45-degree field of view
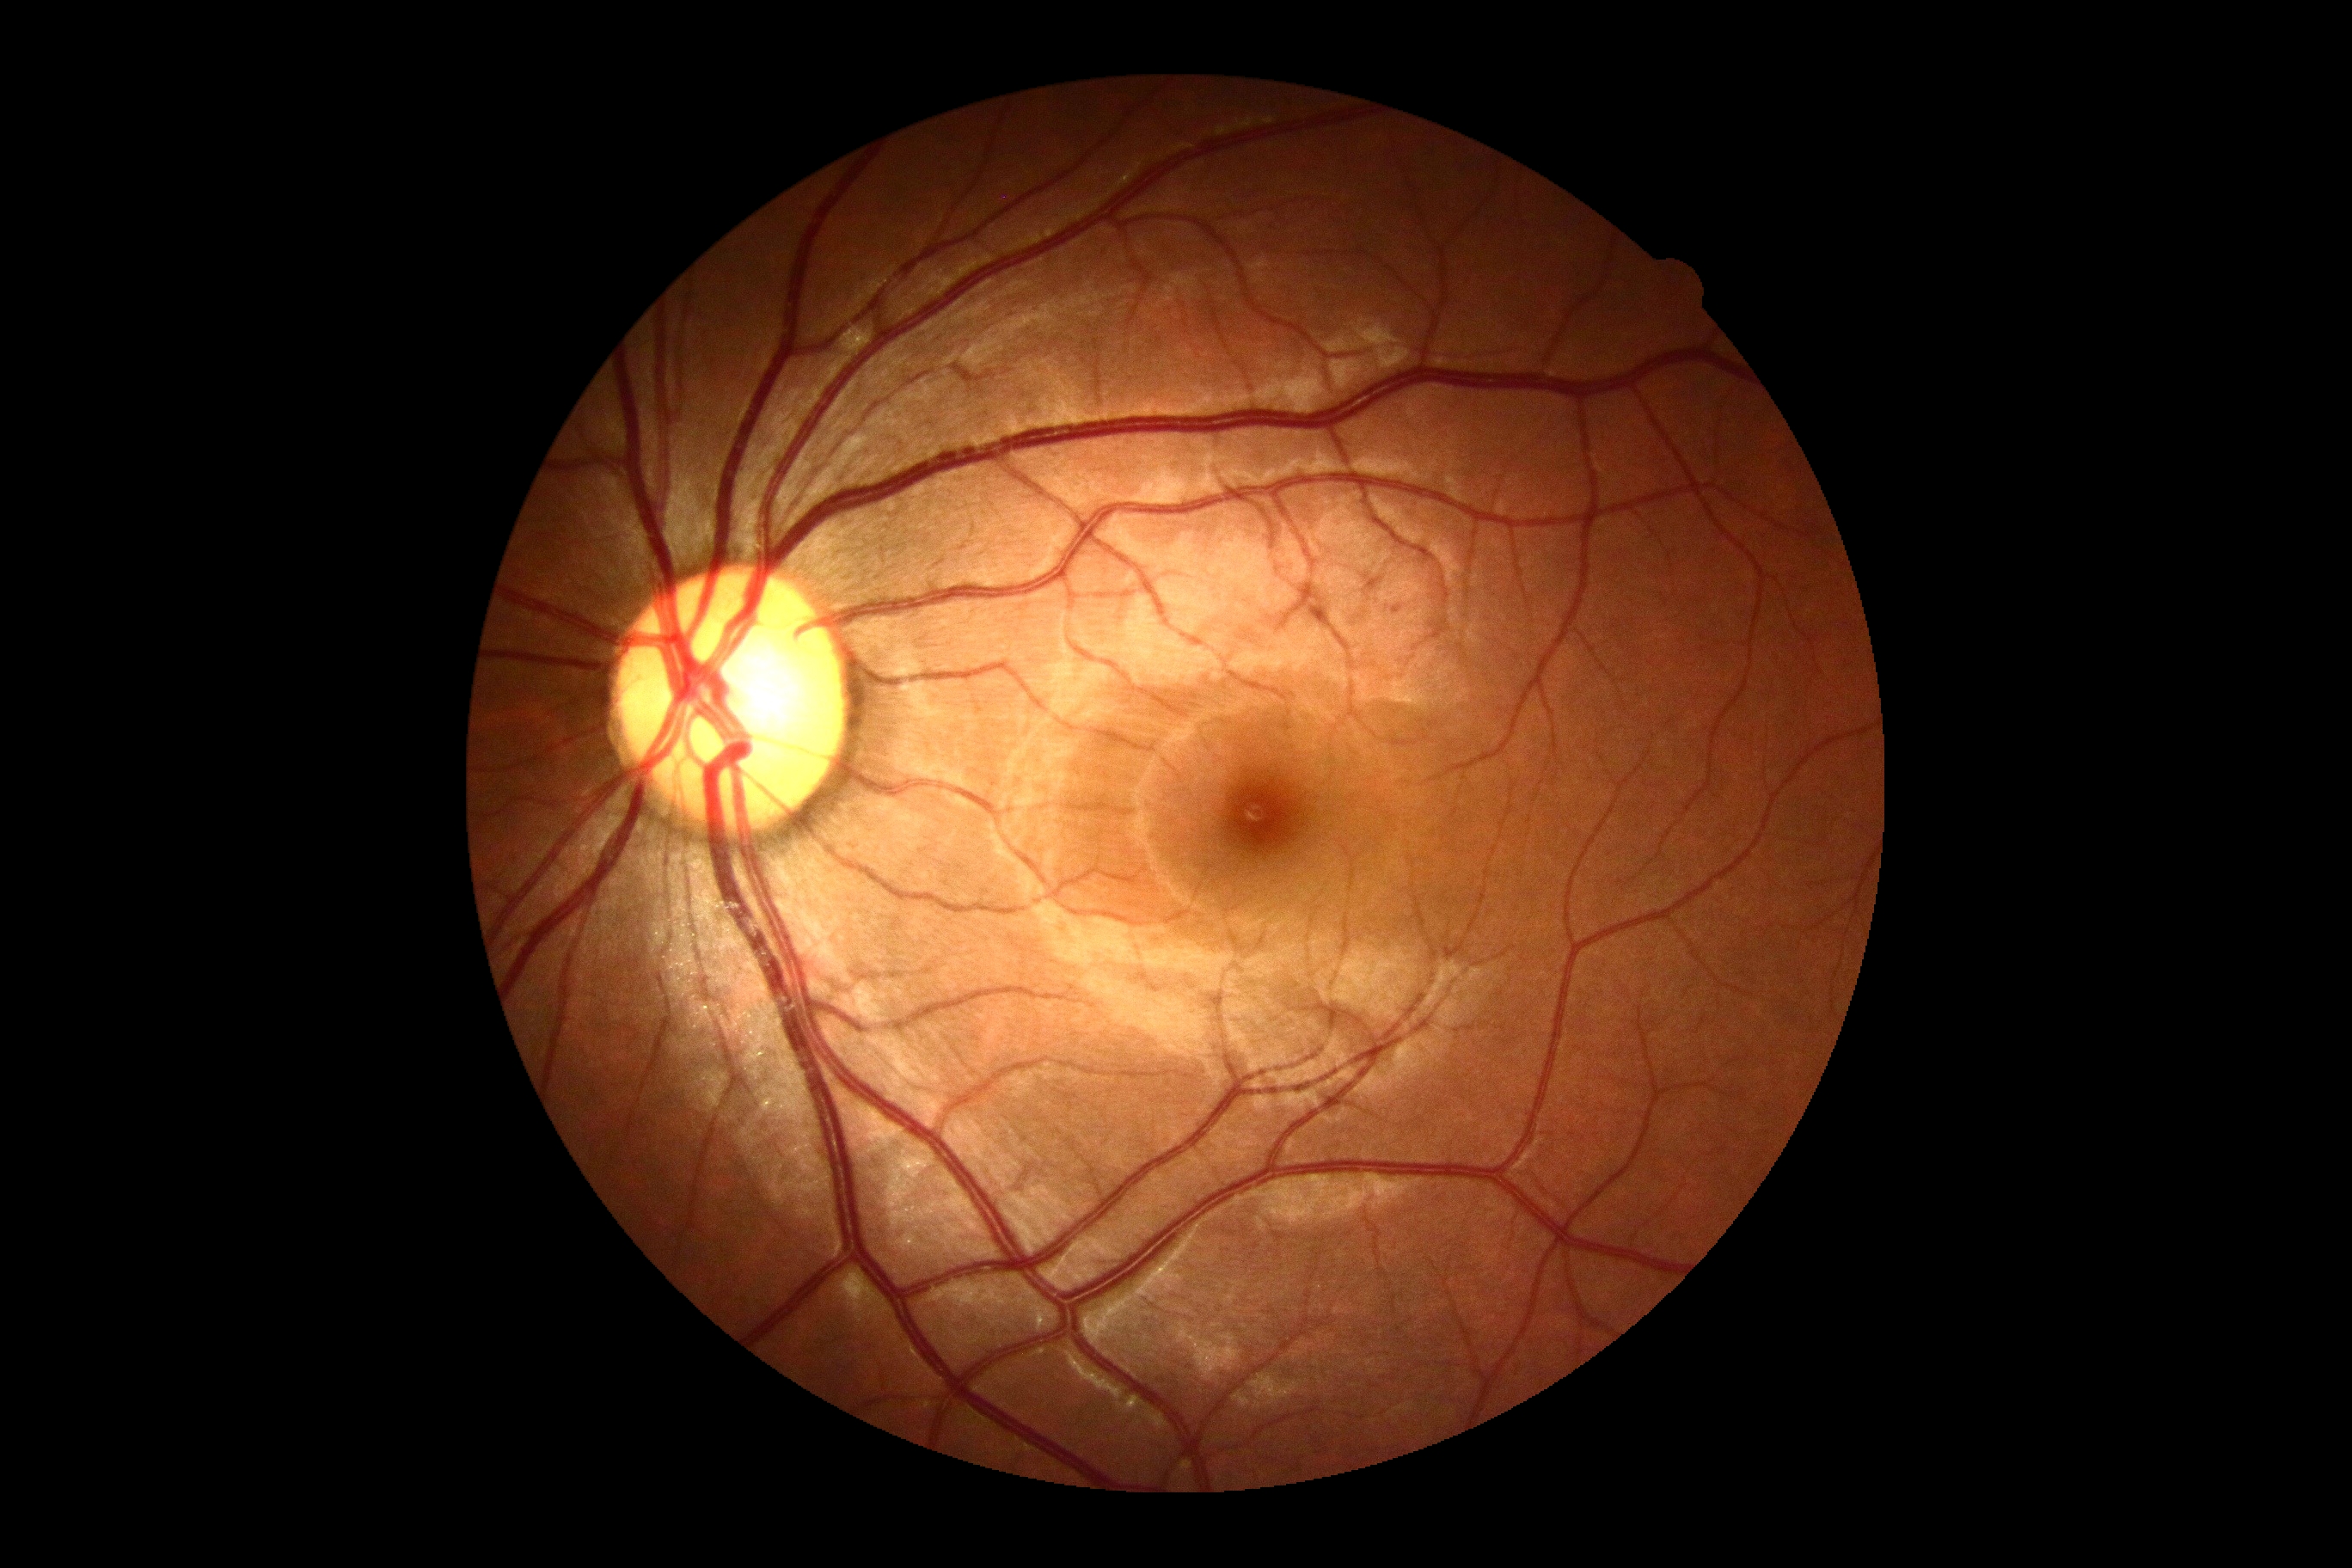
DR severity is no apparent retinopathy (grade 0).